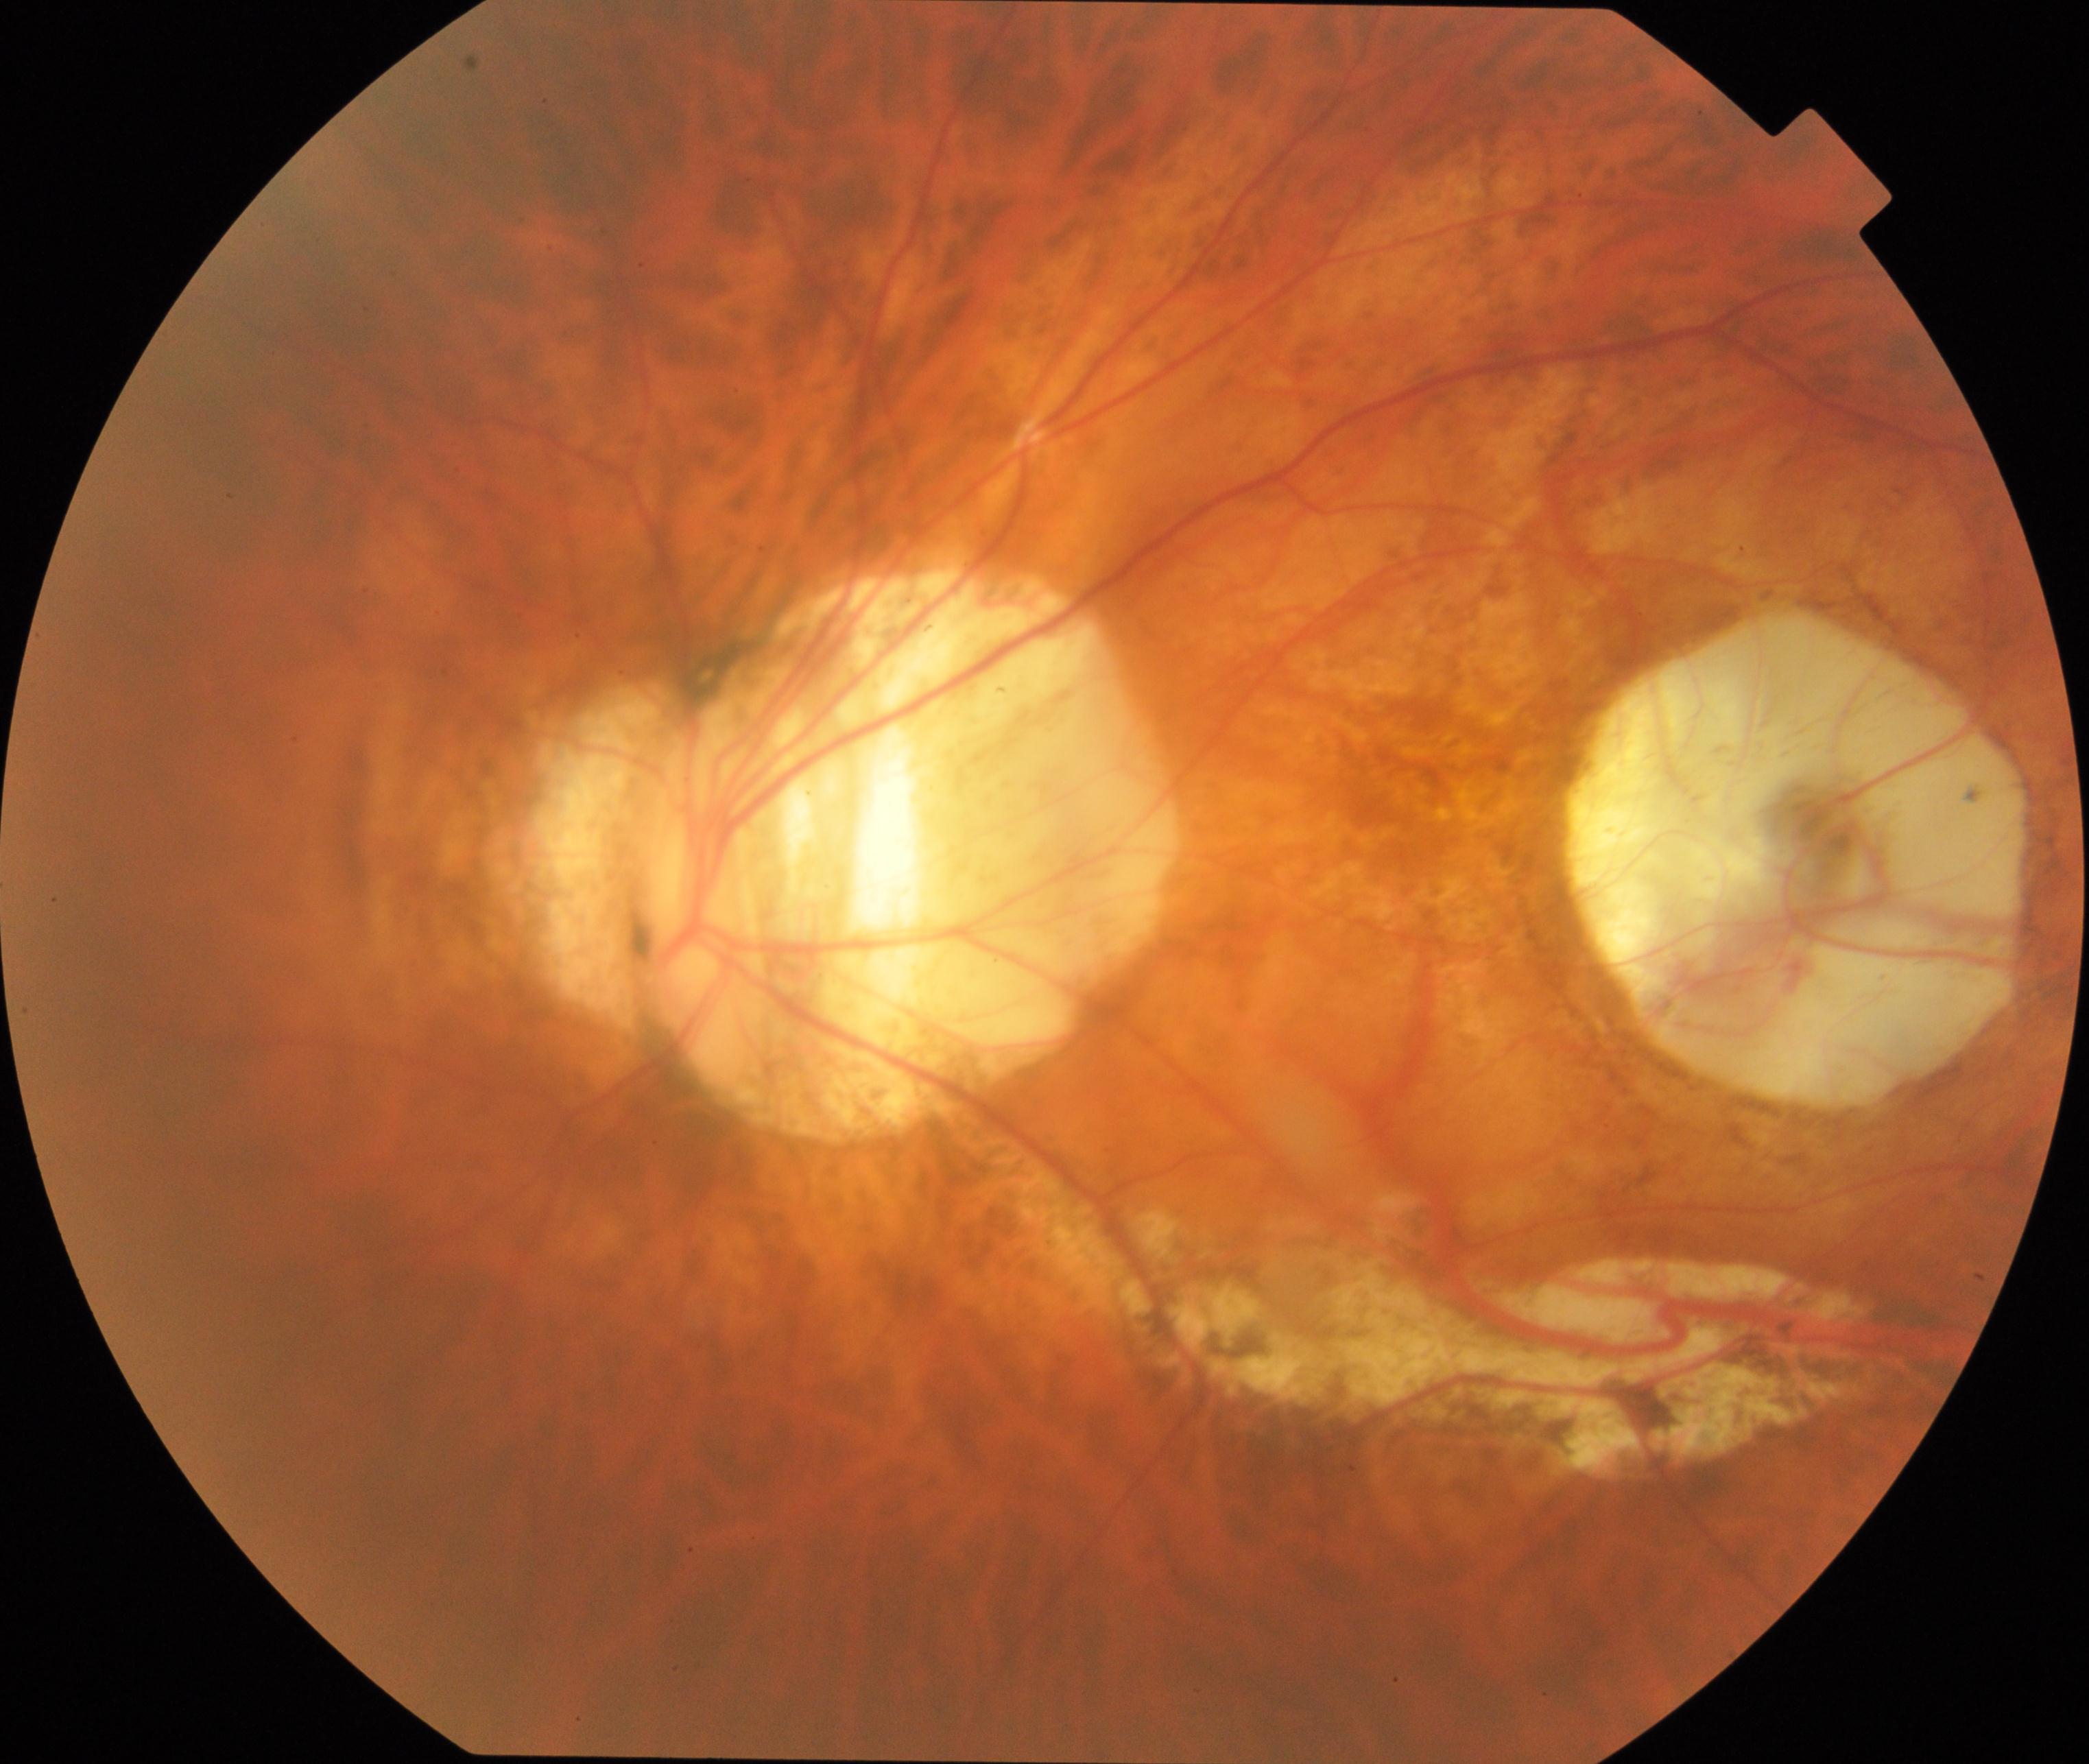 The image shows pathological myopia. Defined by tessellated fundus with focal chorioretinal atrophy, Fuchs spot, lacquer cracks, choroidal neovascularization, or subretinal hemorrhage.